Ultra-widefield fundus photograph, 1924 x 1556 pixels, 200-degree field of view — 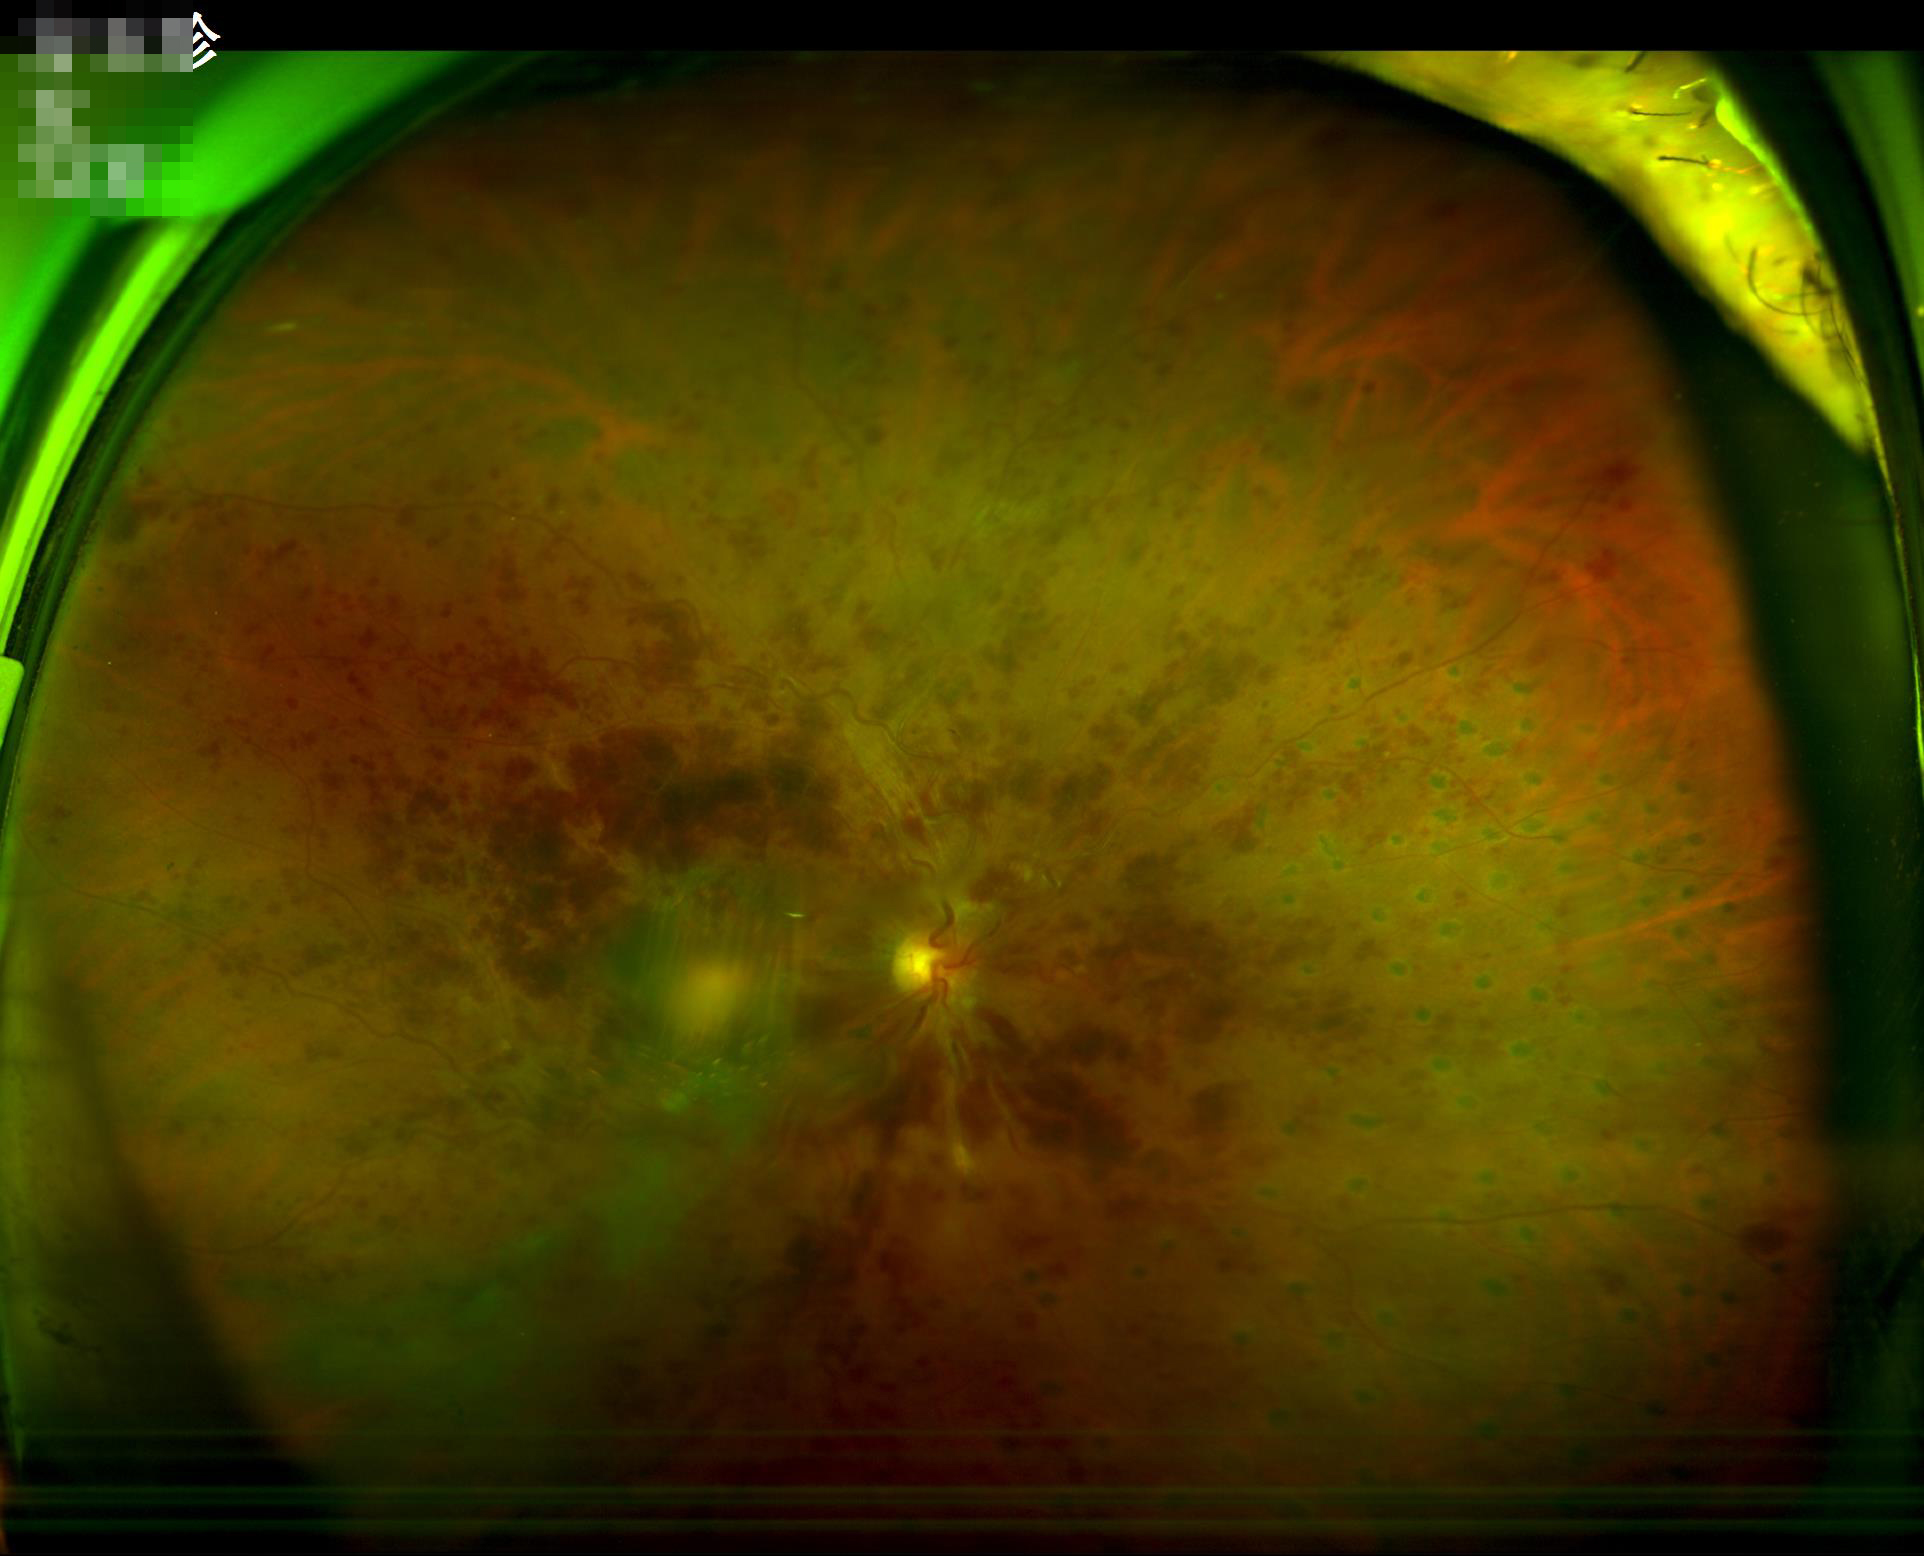 Illumination: even; Clarity: poor; Contrast: poor; Overall image quality: low.